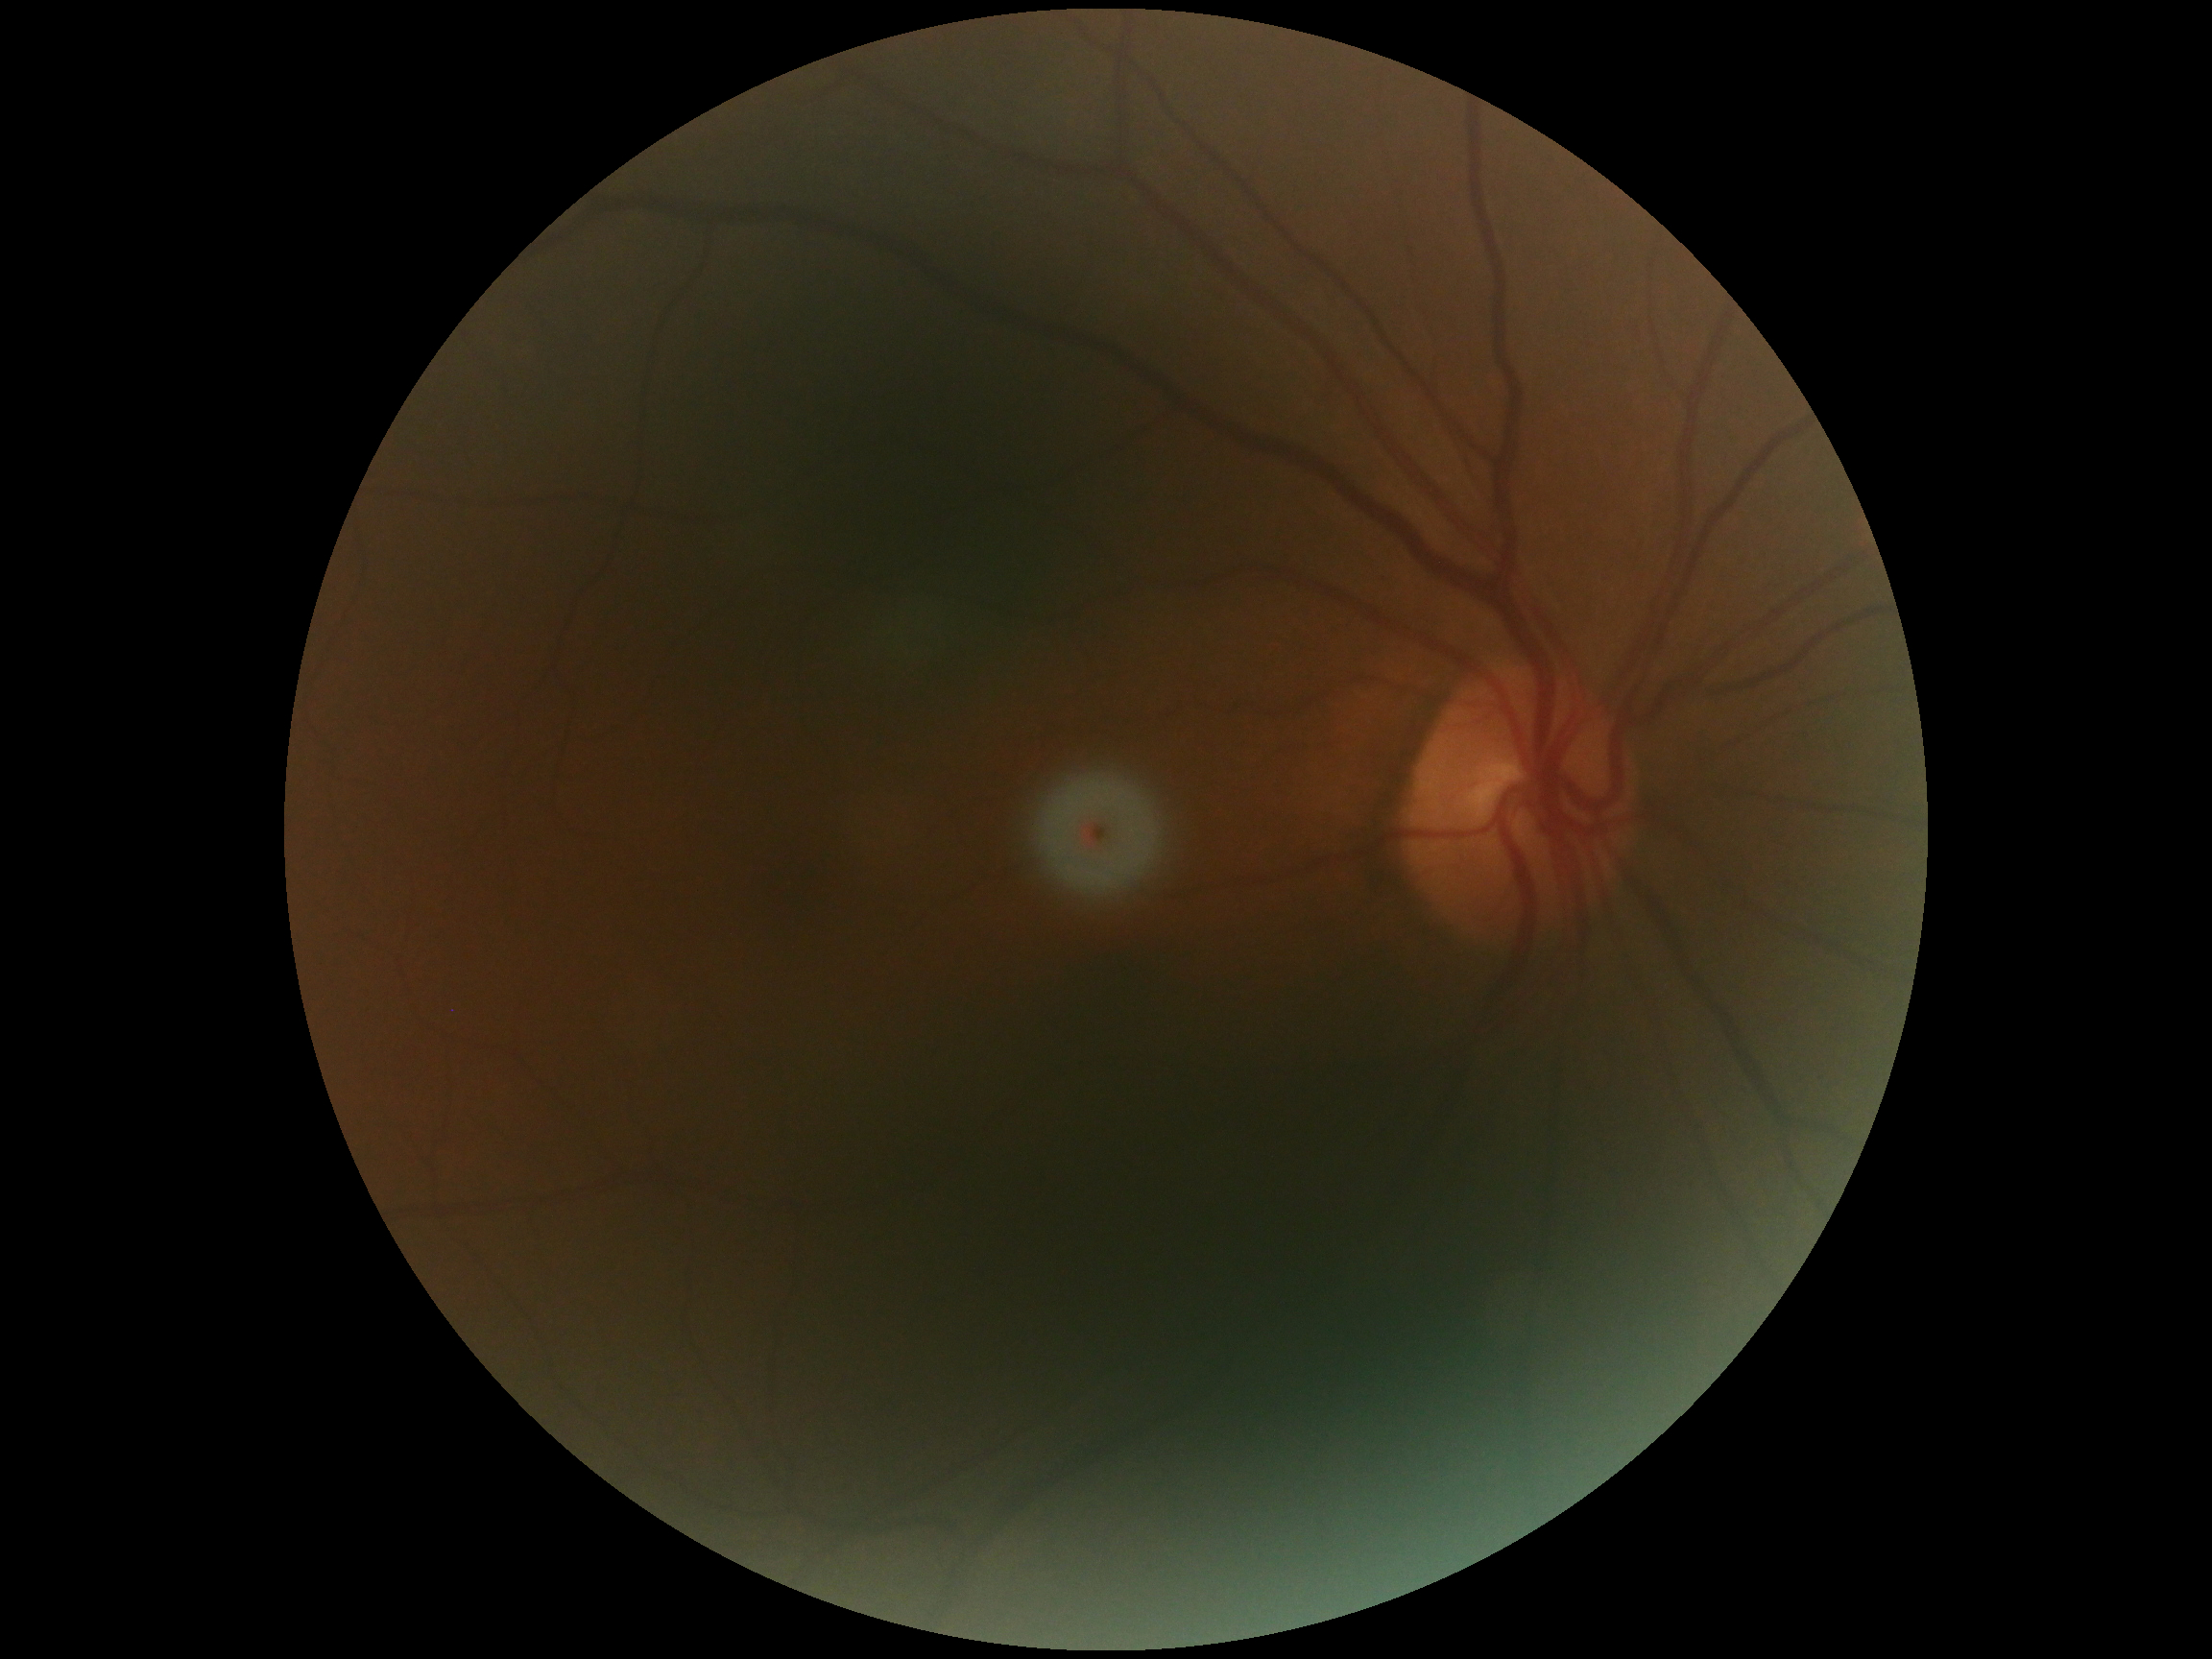

Diabetic retinopathy (DR) is 0.